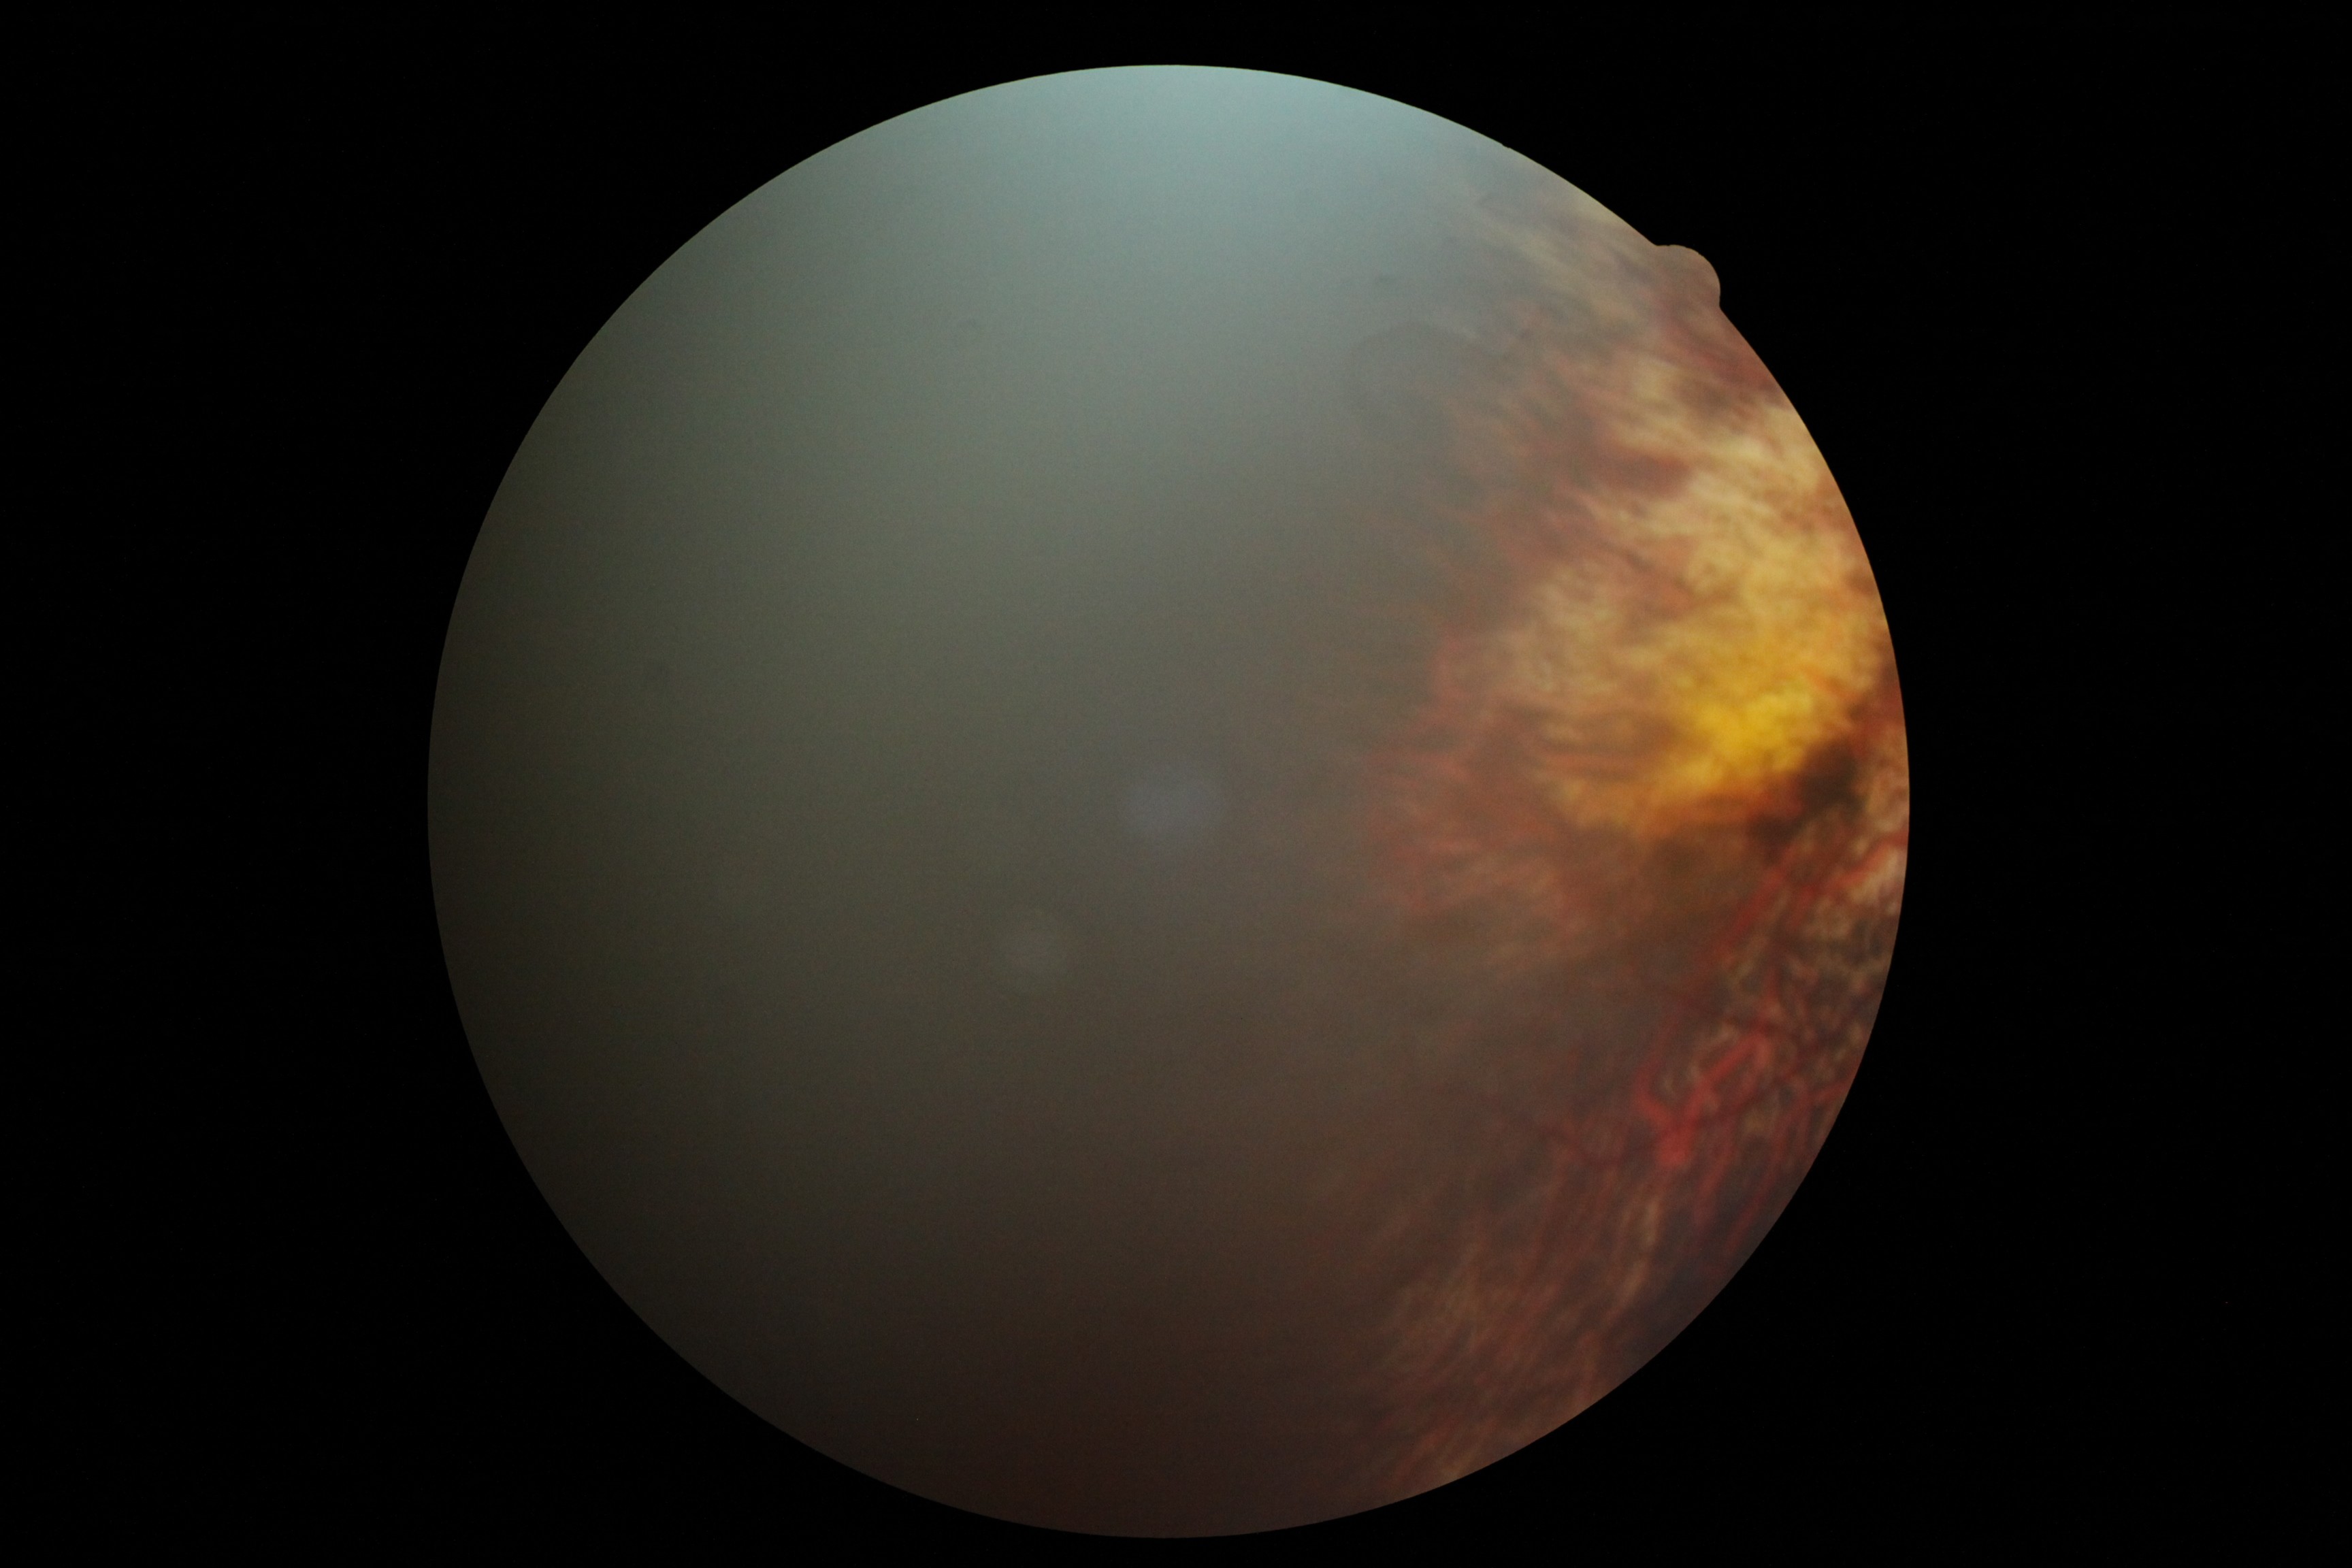

diabetic retinopathy = ungradable, image quality = insufficient.